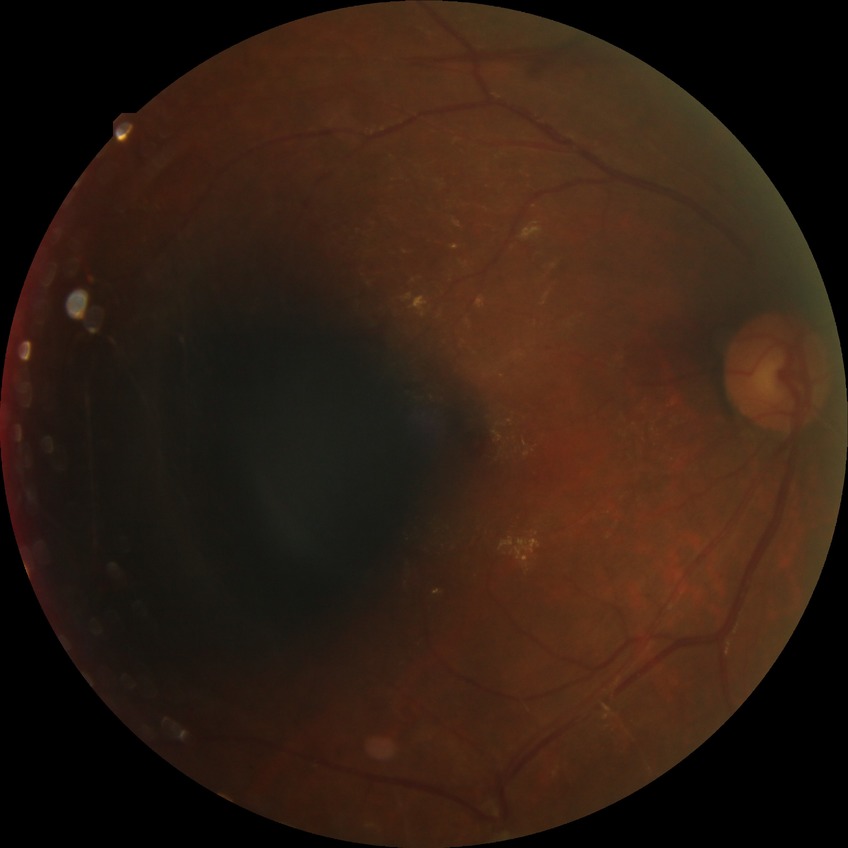

{"davis_grade": "proliferative diabetic retinopathy"}